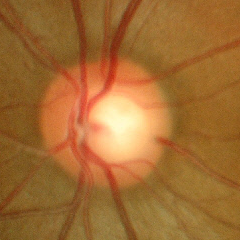

Demonstrates no glaucomatous findings.